2212x1659px. Retinal fundus photograph: 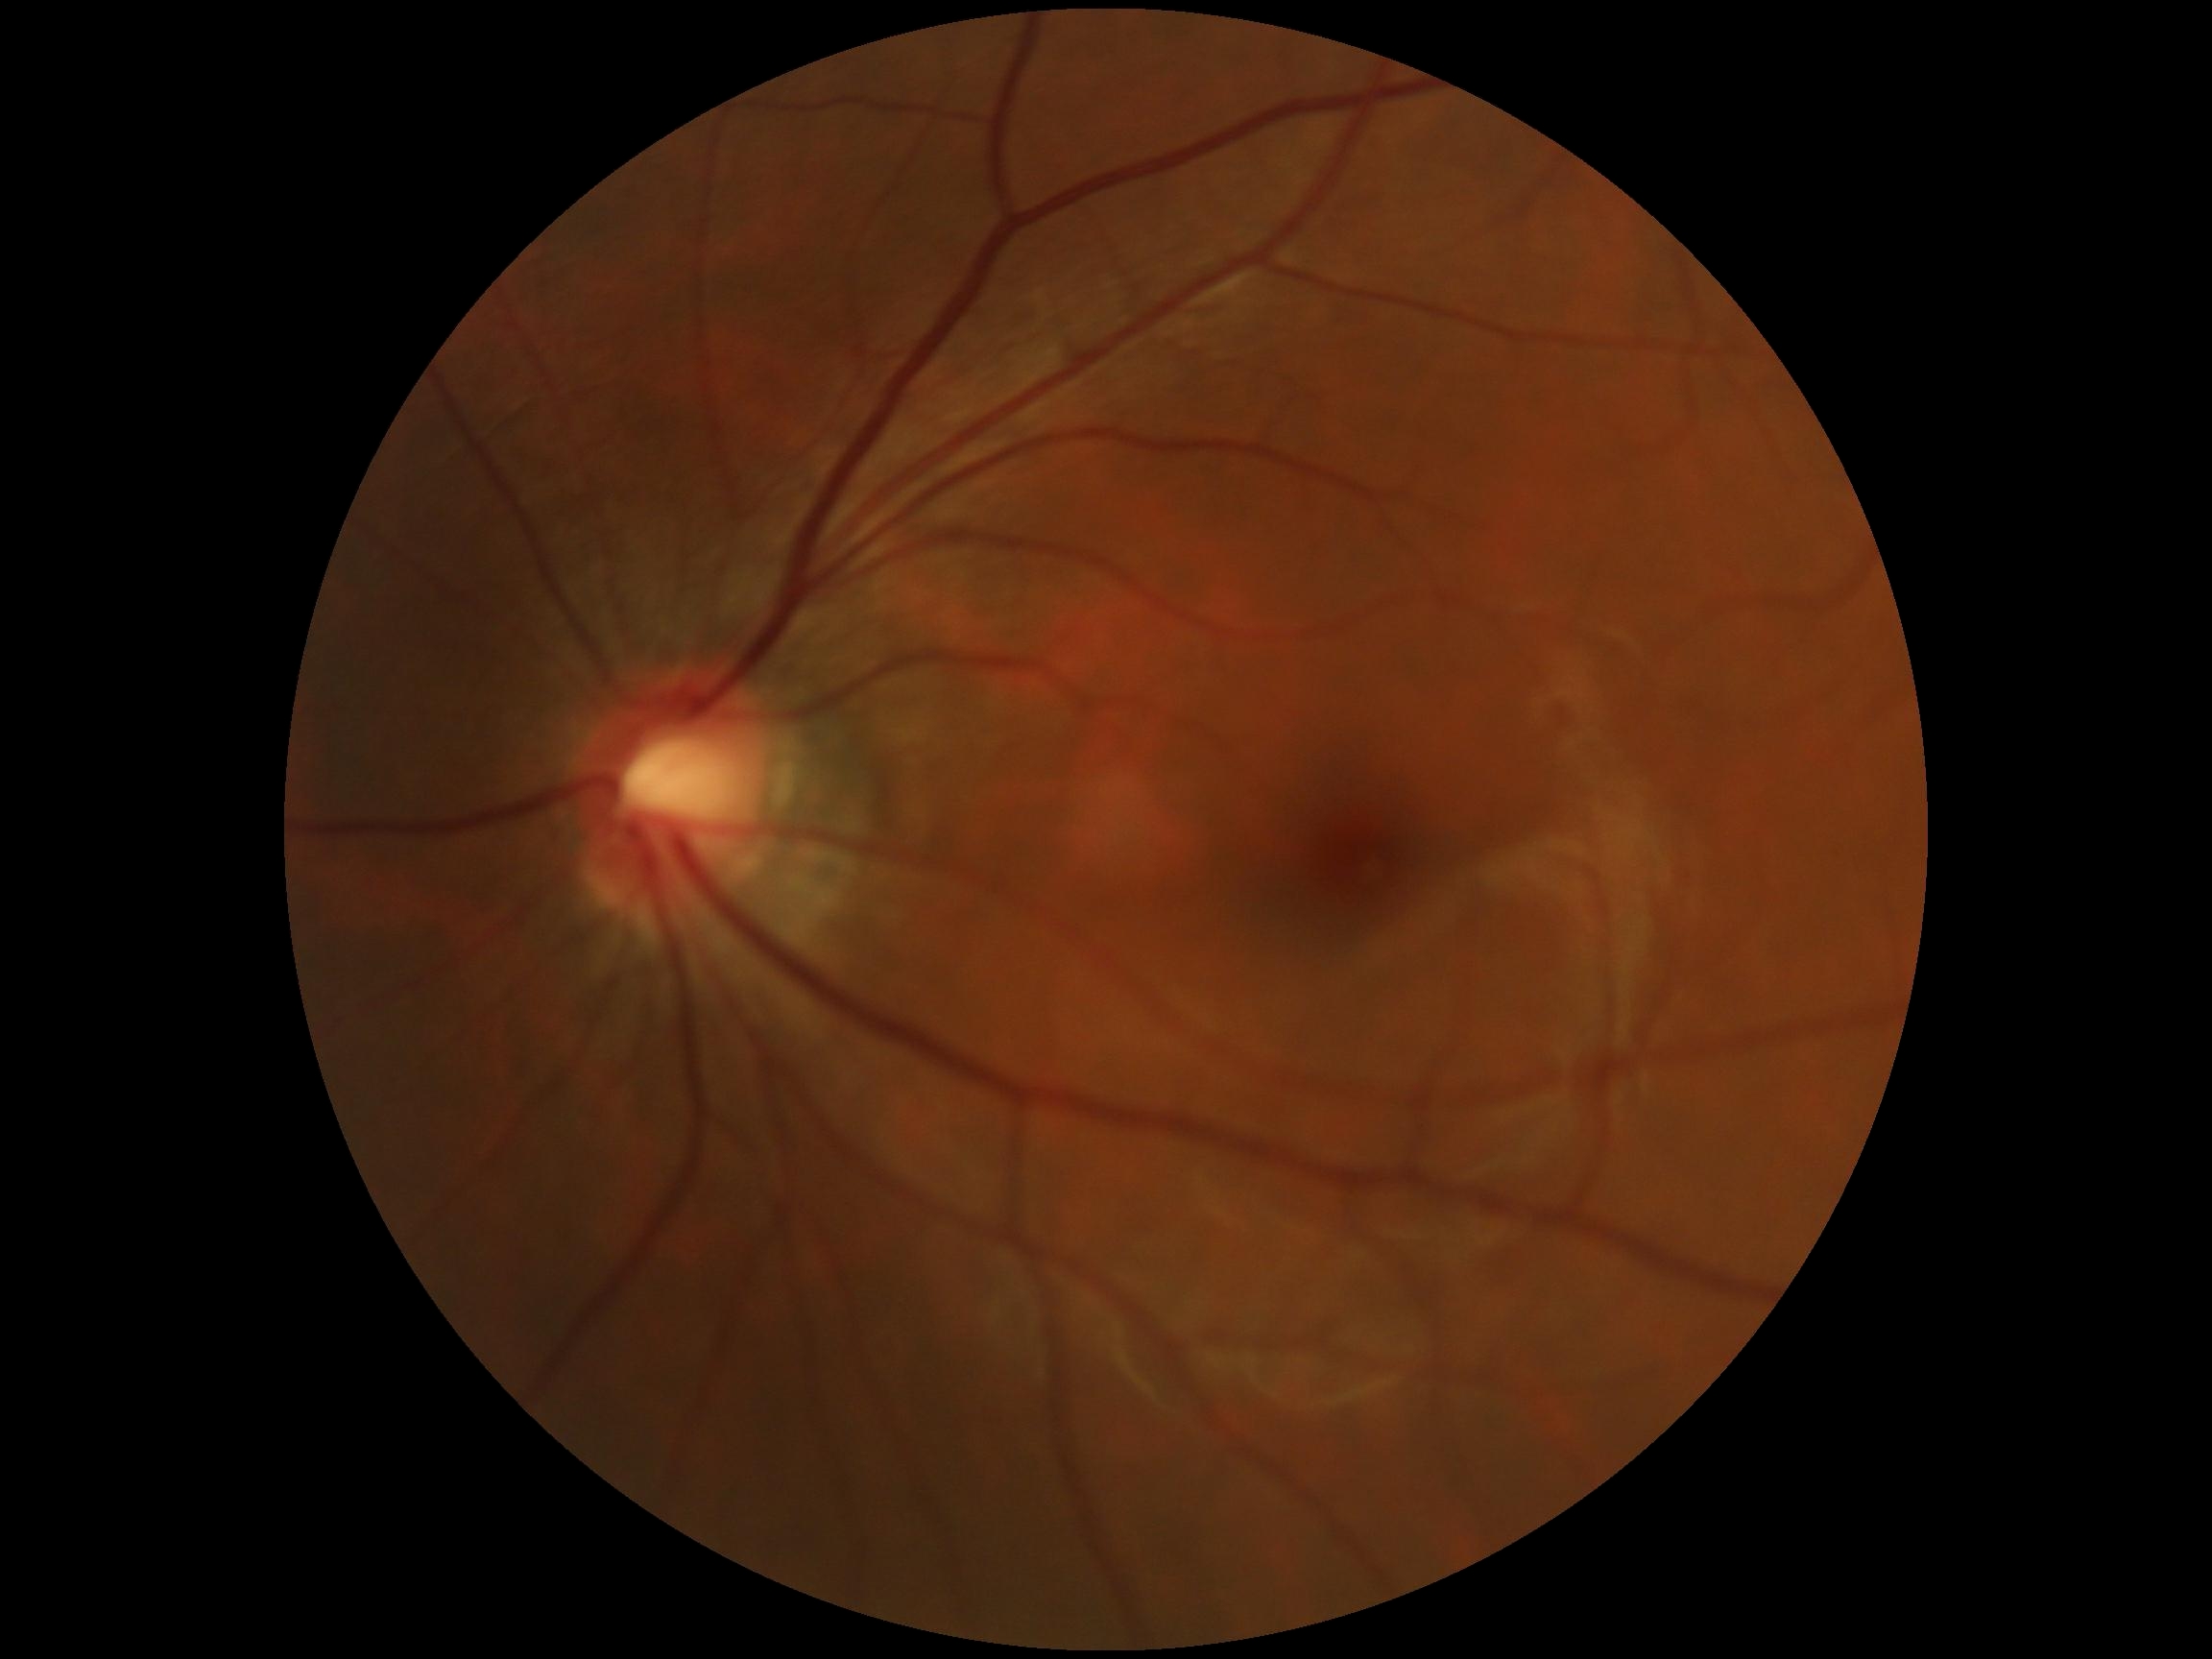

DR impression: no apparent DR; DR grade: no apparent diabetic retinopathy (0).